Acquired on the Phoenix ICON. Wide-field fundus photograph of an infant
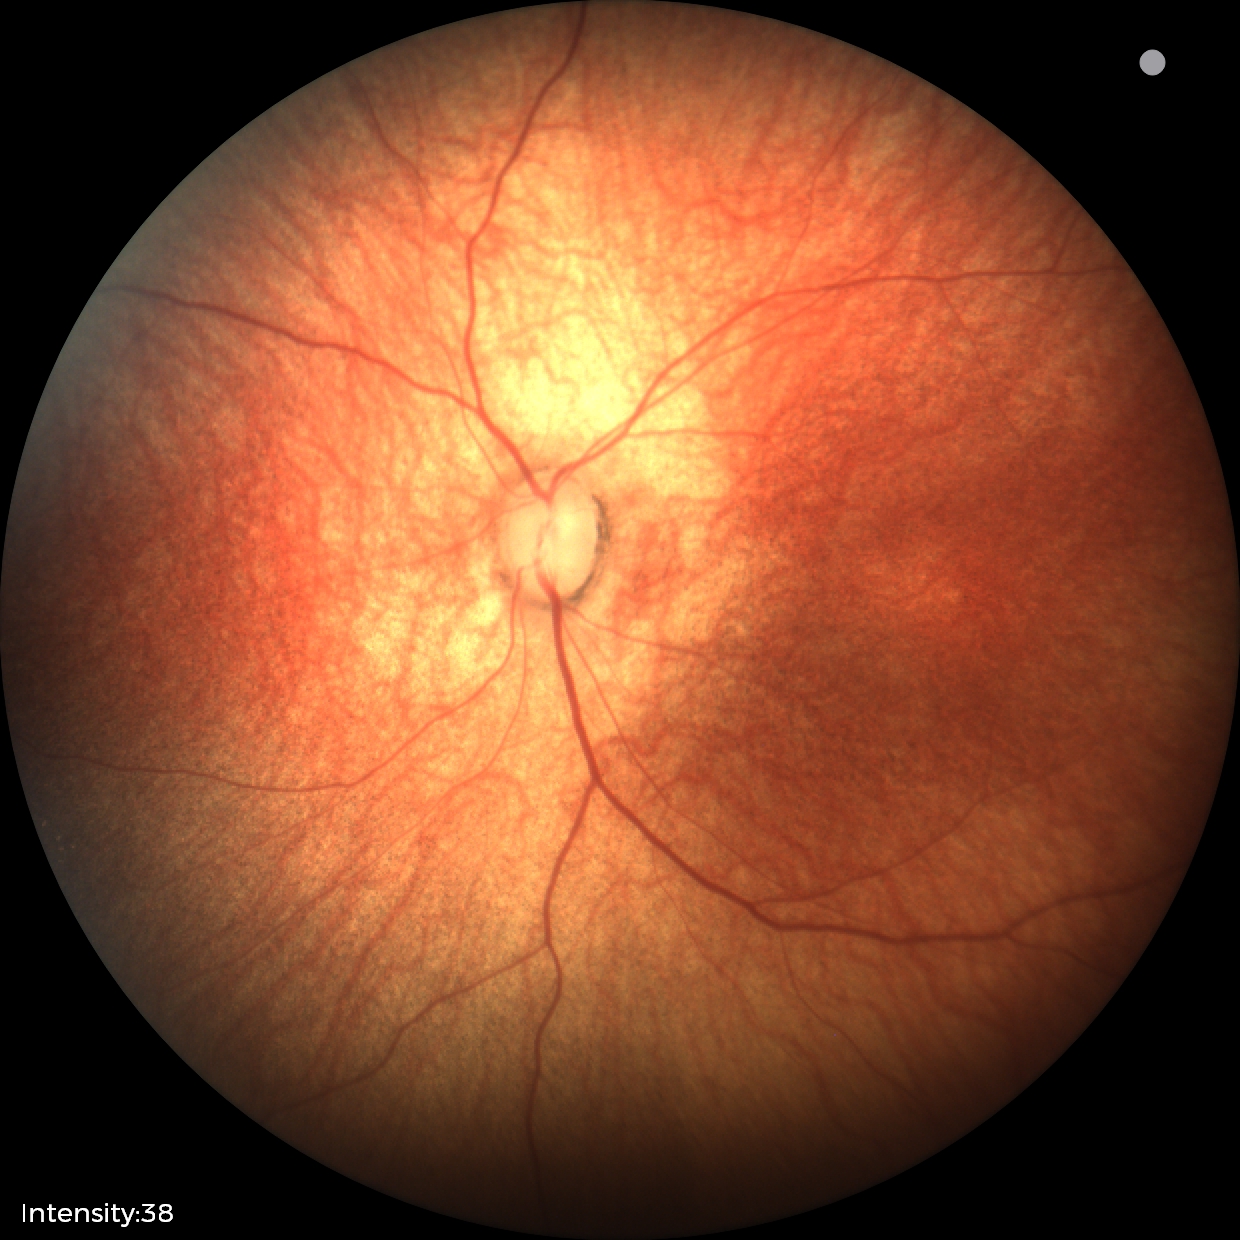

Normal screening examination.